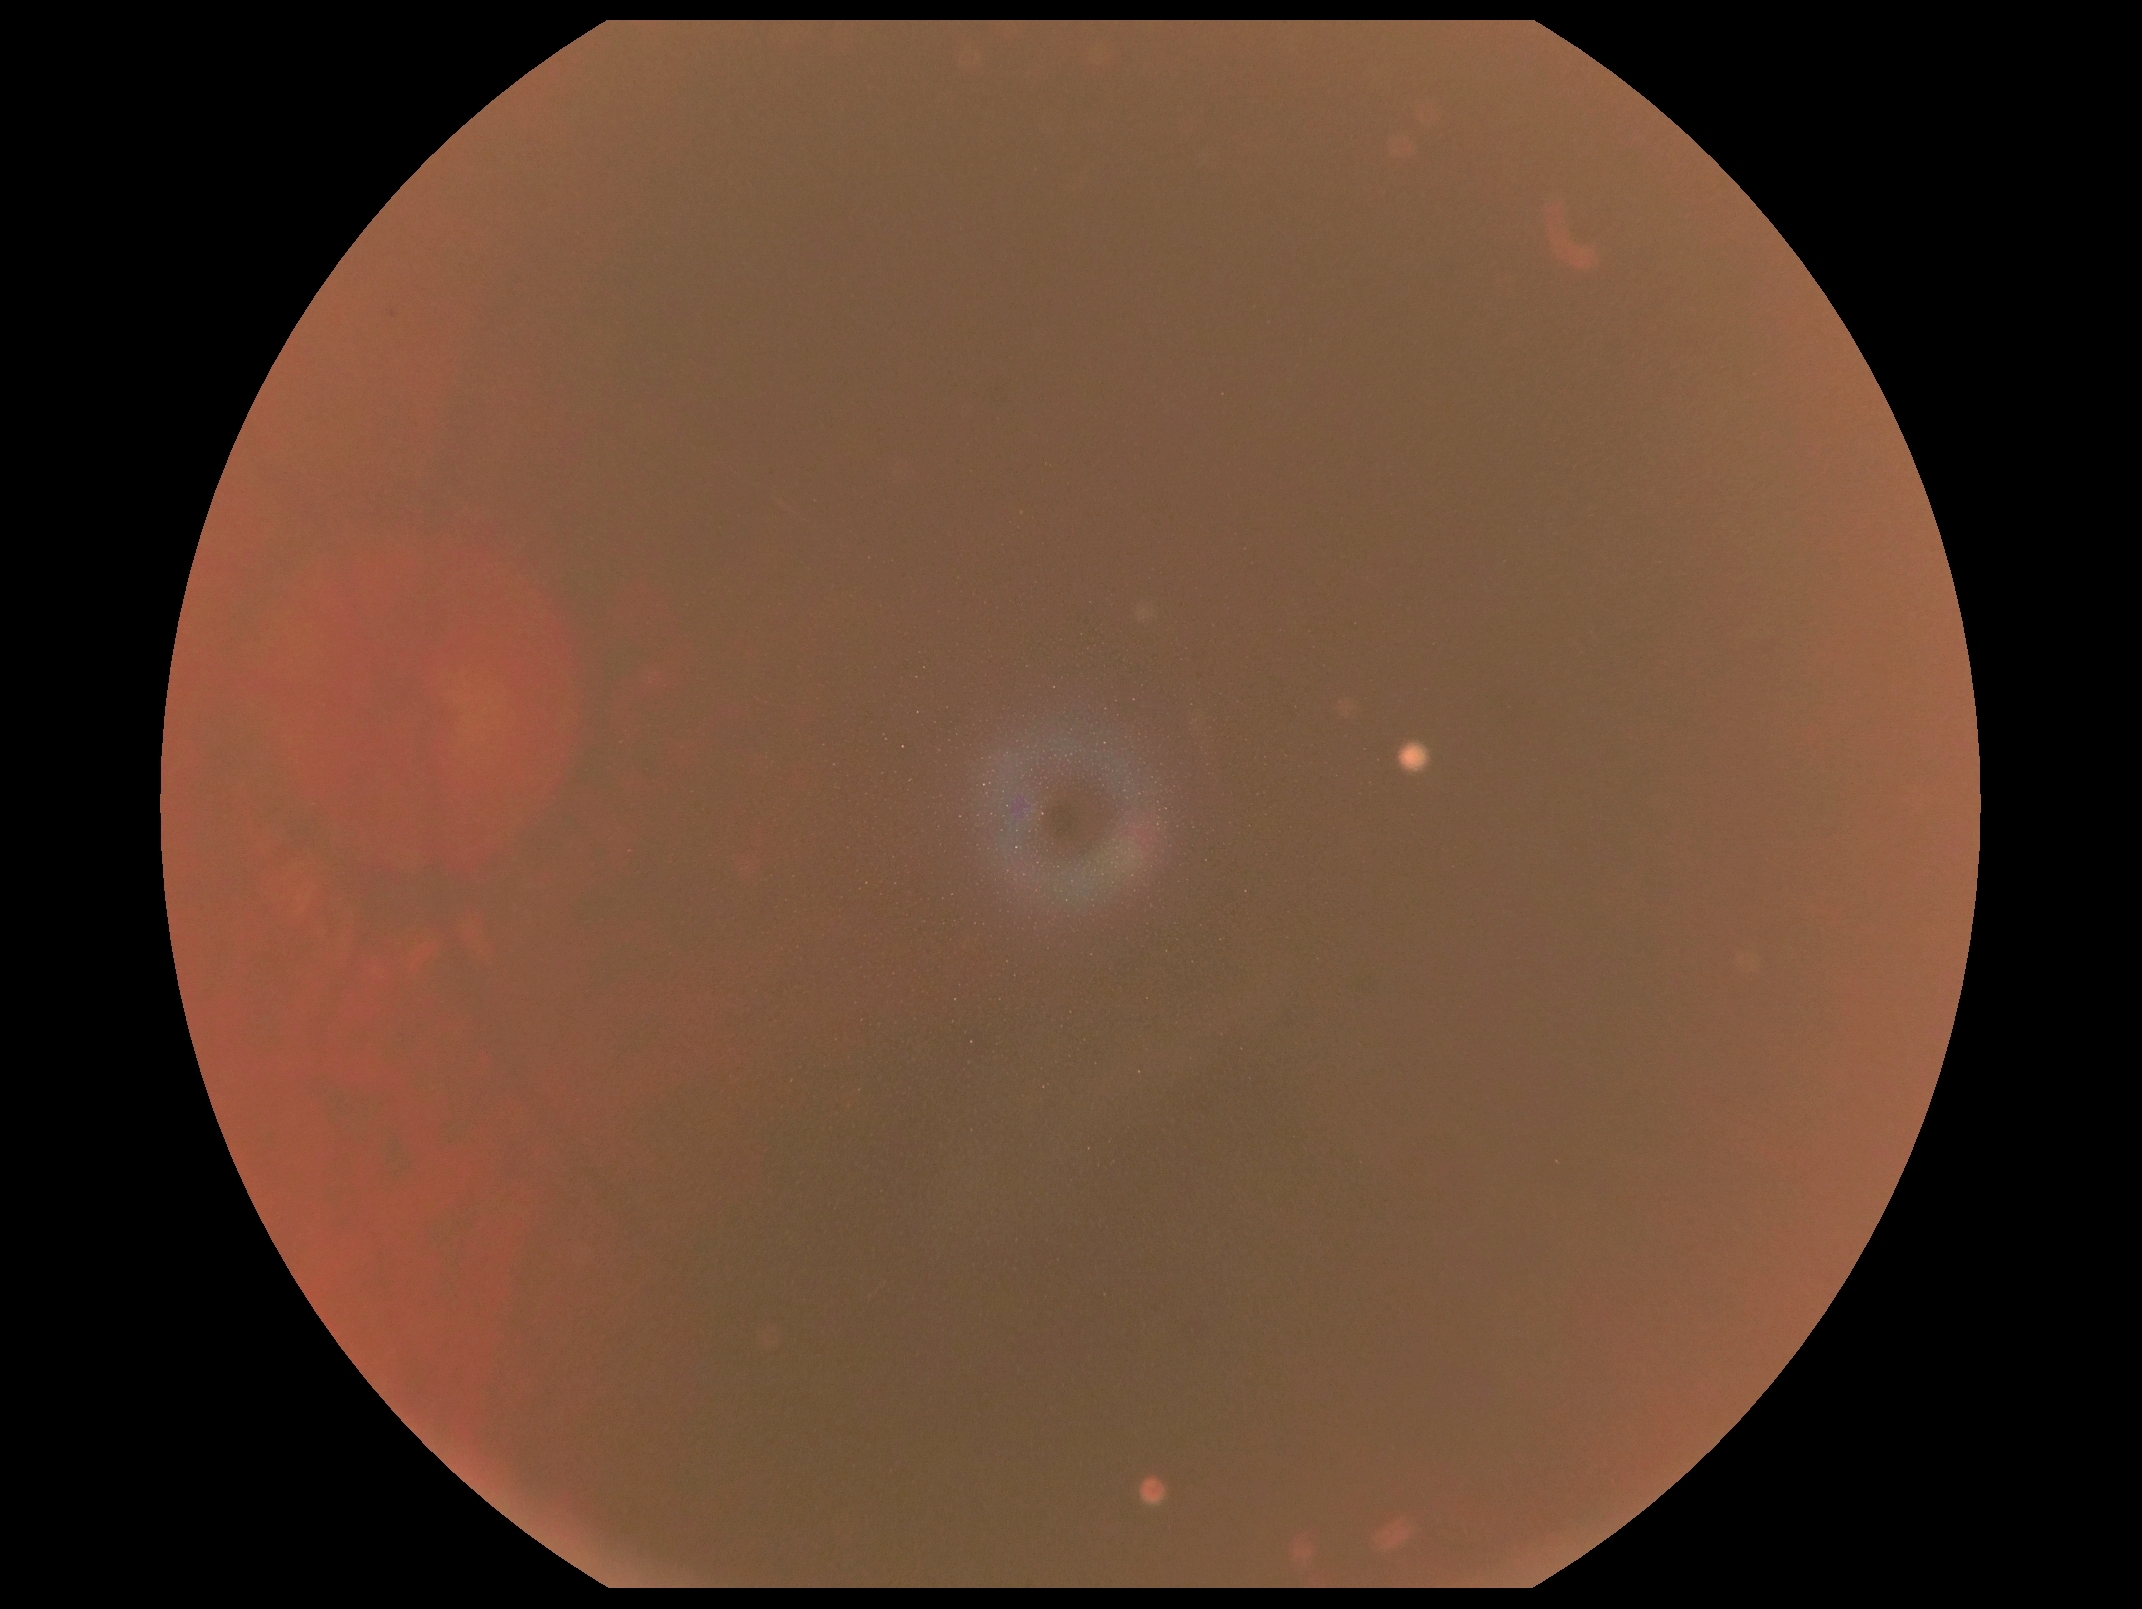

DR is ungradable due to poor image quality.